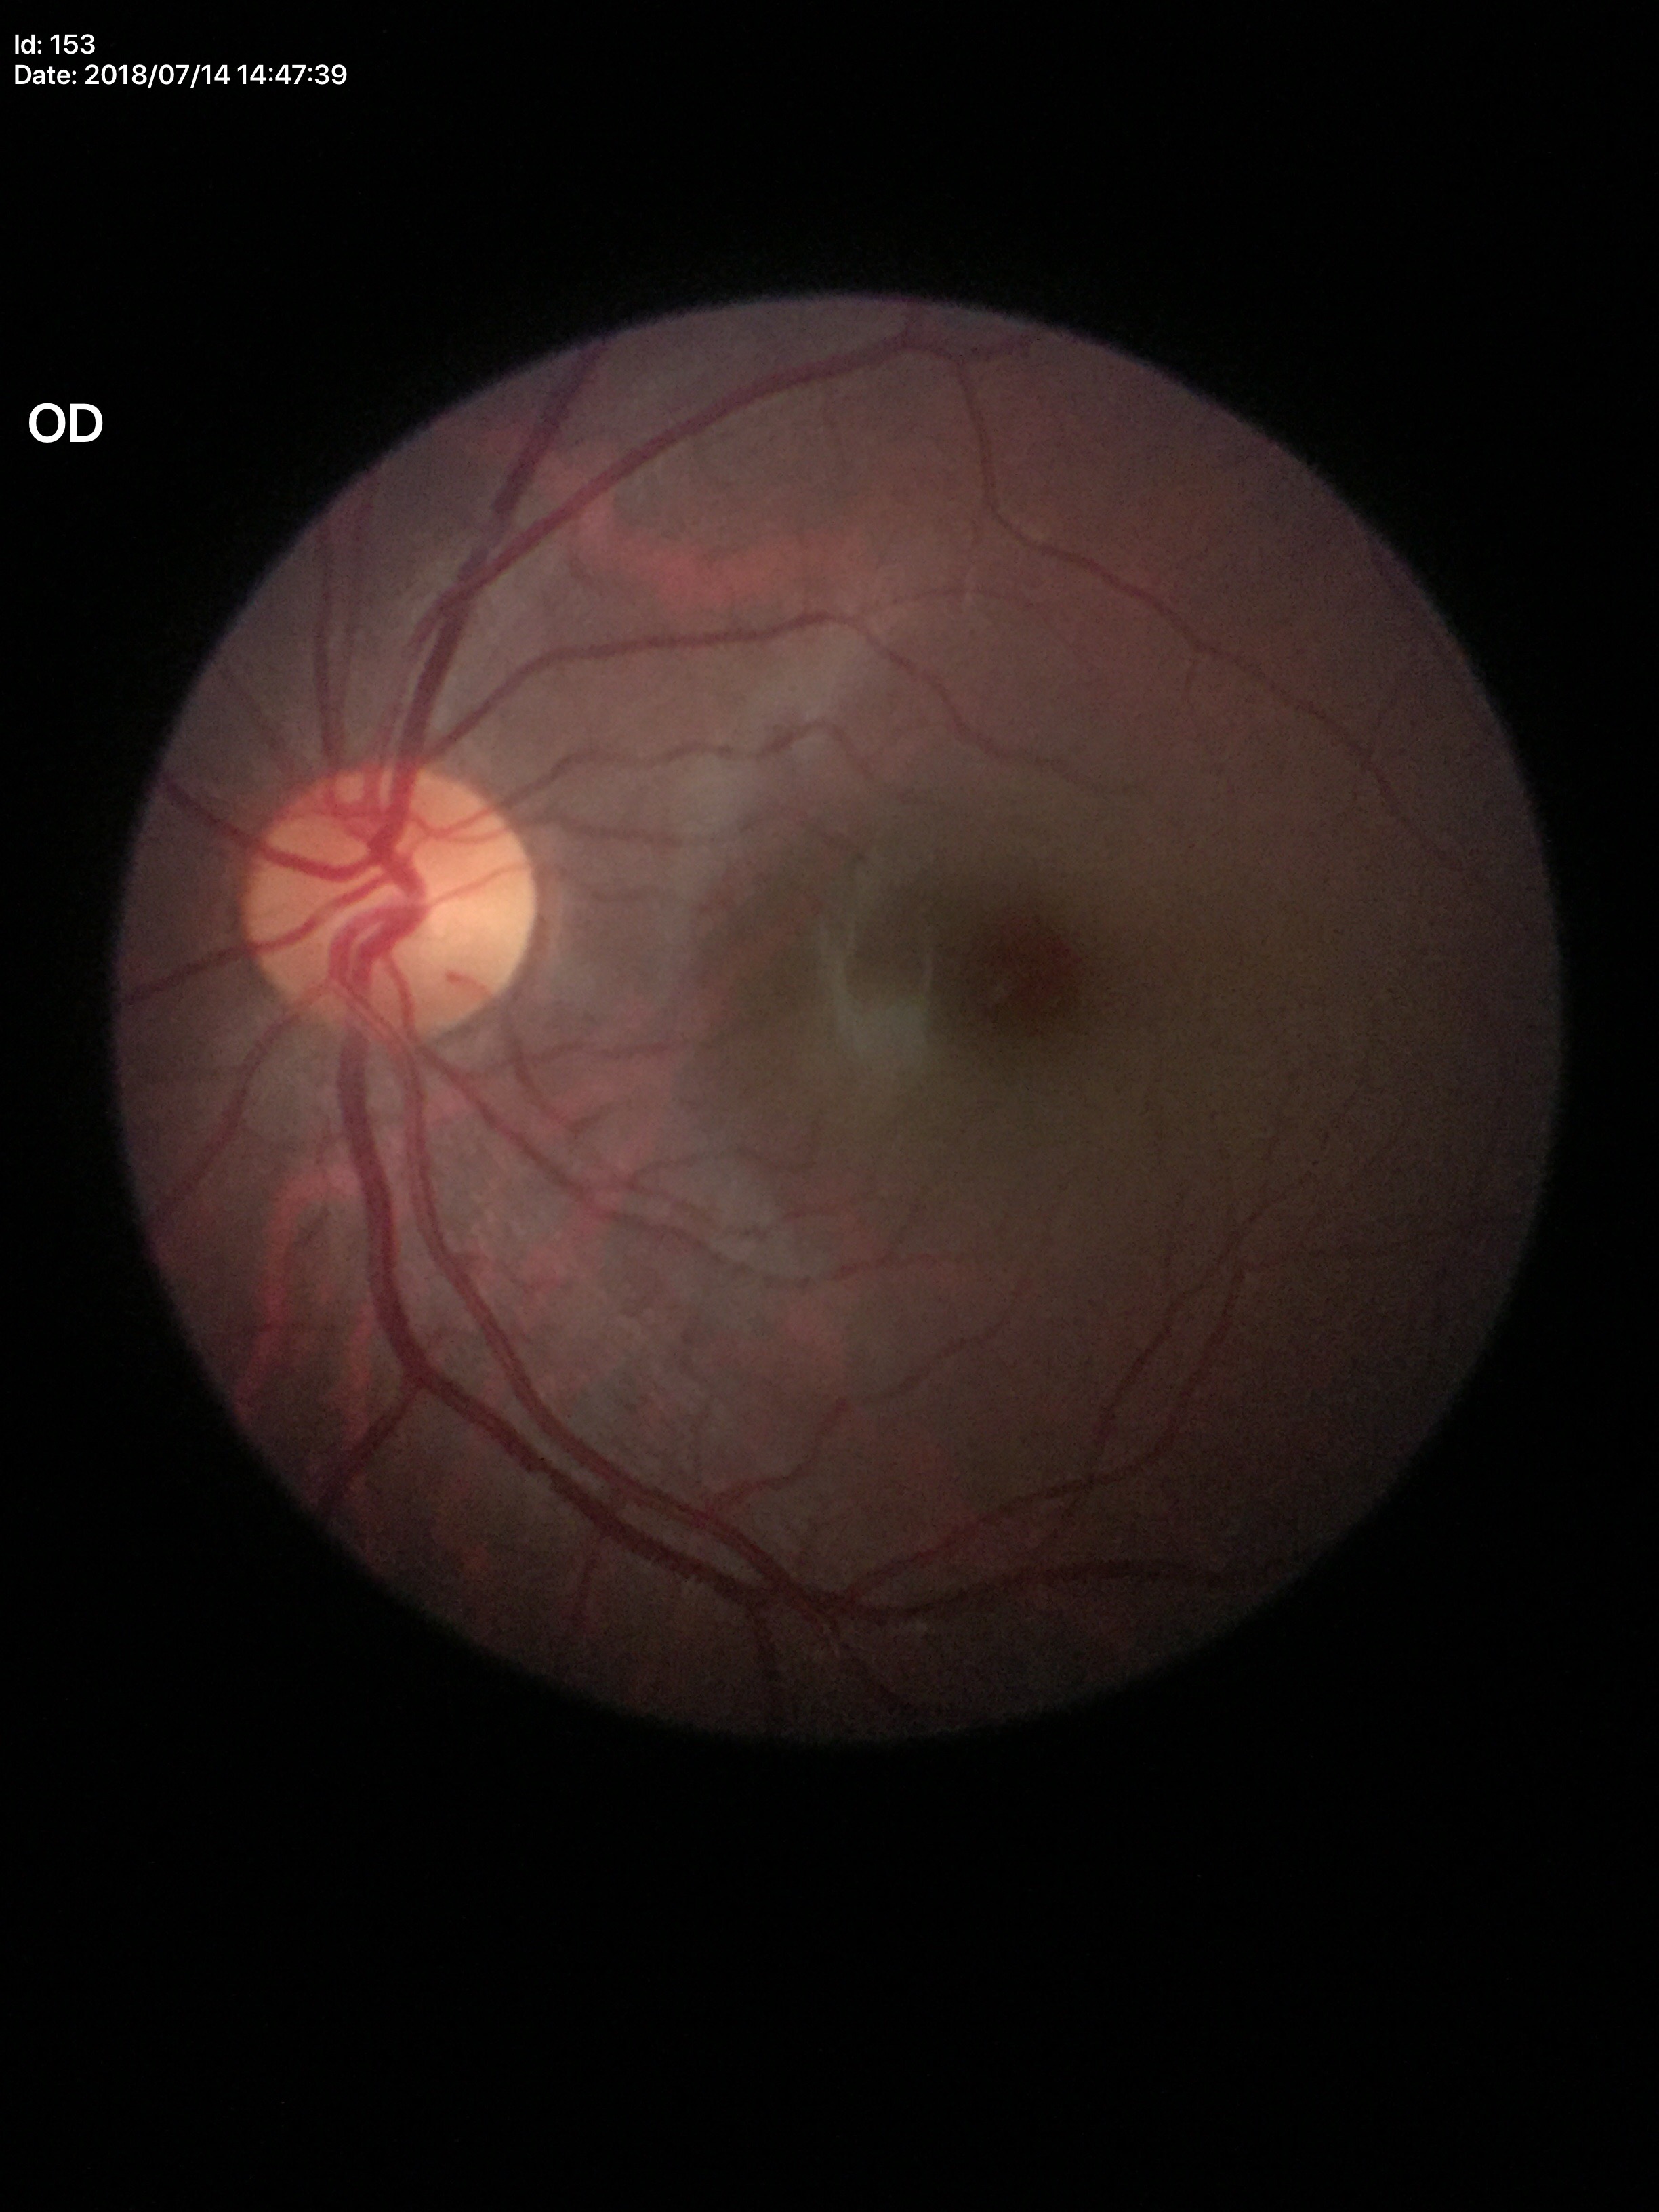 Q: What is the VCDR?
A: 0.47
Q: Glaucoma screening result?
A: no suspicious findings
Q: Horizontal CDR?
A: 0.49